848x848px; Davis DR grading; FOV: 45 degrees; no pharmacologic dilation — 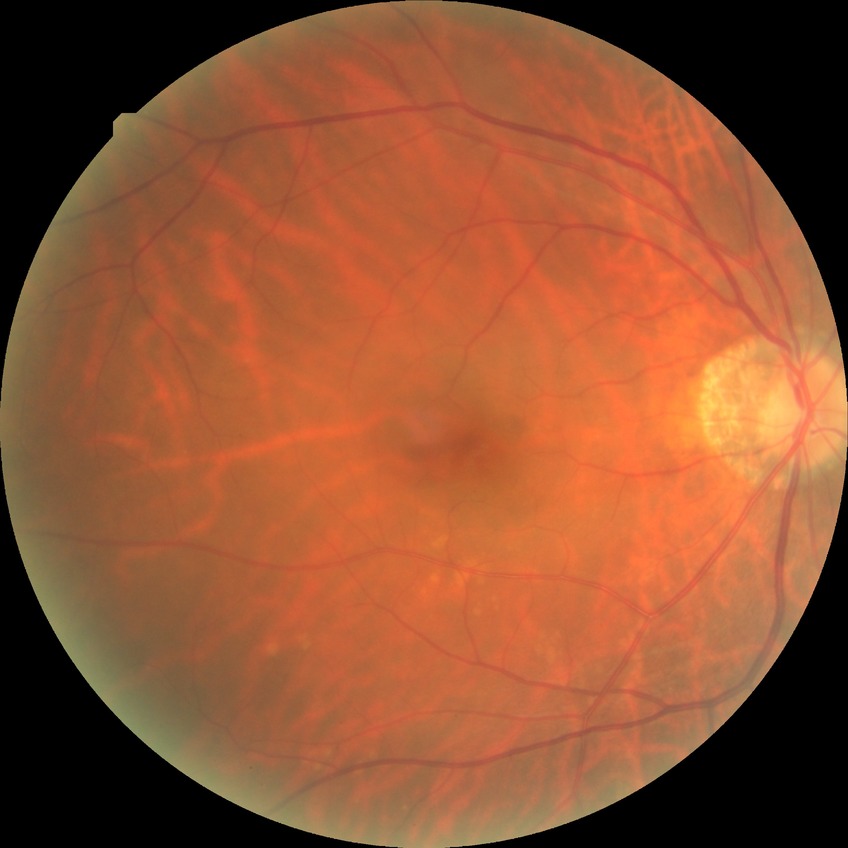

Assessment:
- modified Davis classification: no diabetic retinopathy